848x848 · camera: NIDEK AFC-230 — 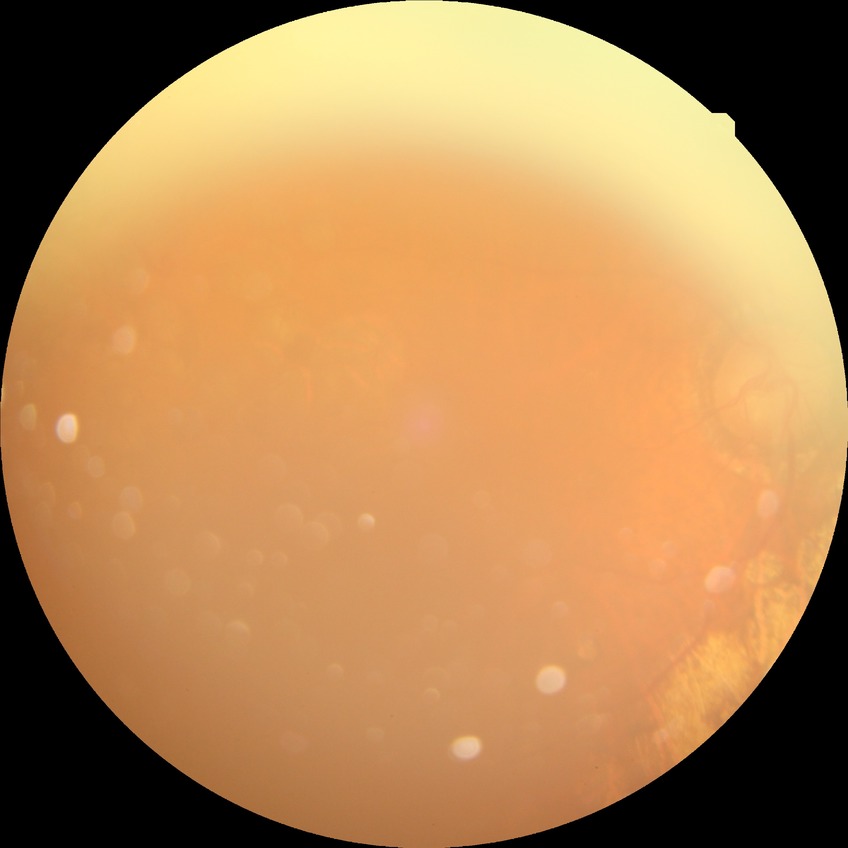

{
  "davis_grade": "proliferative diabetic retinopathy (PDR)"
}